45° FOV. Color fundus photograph
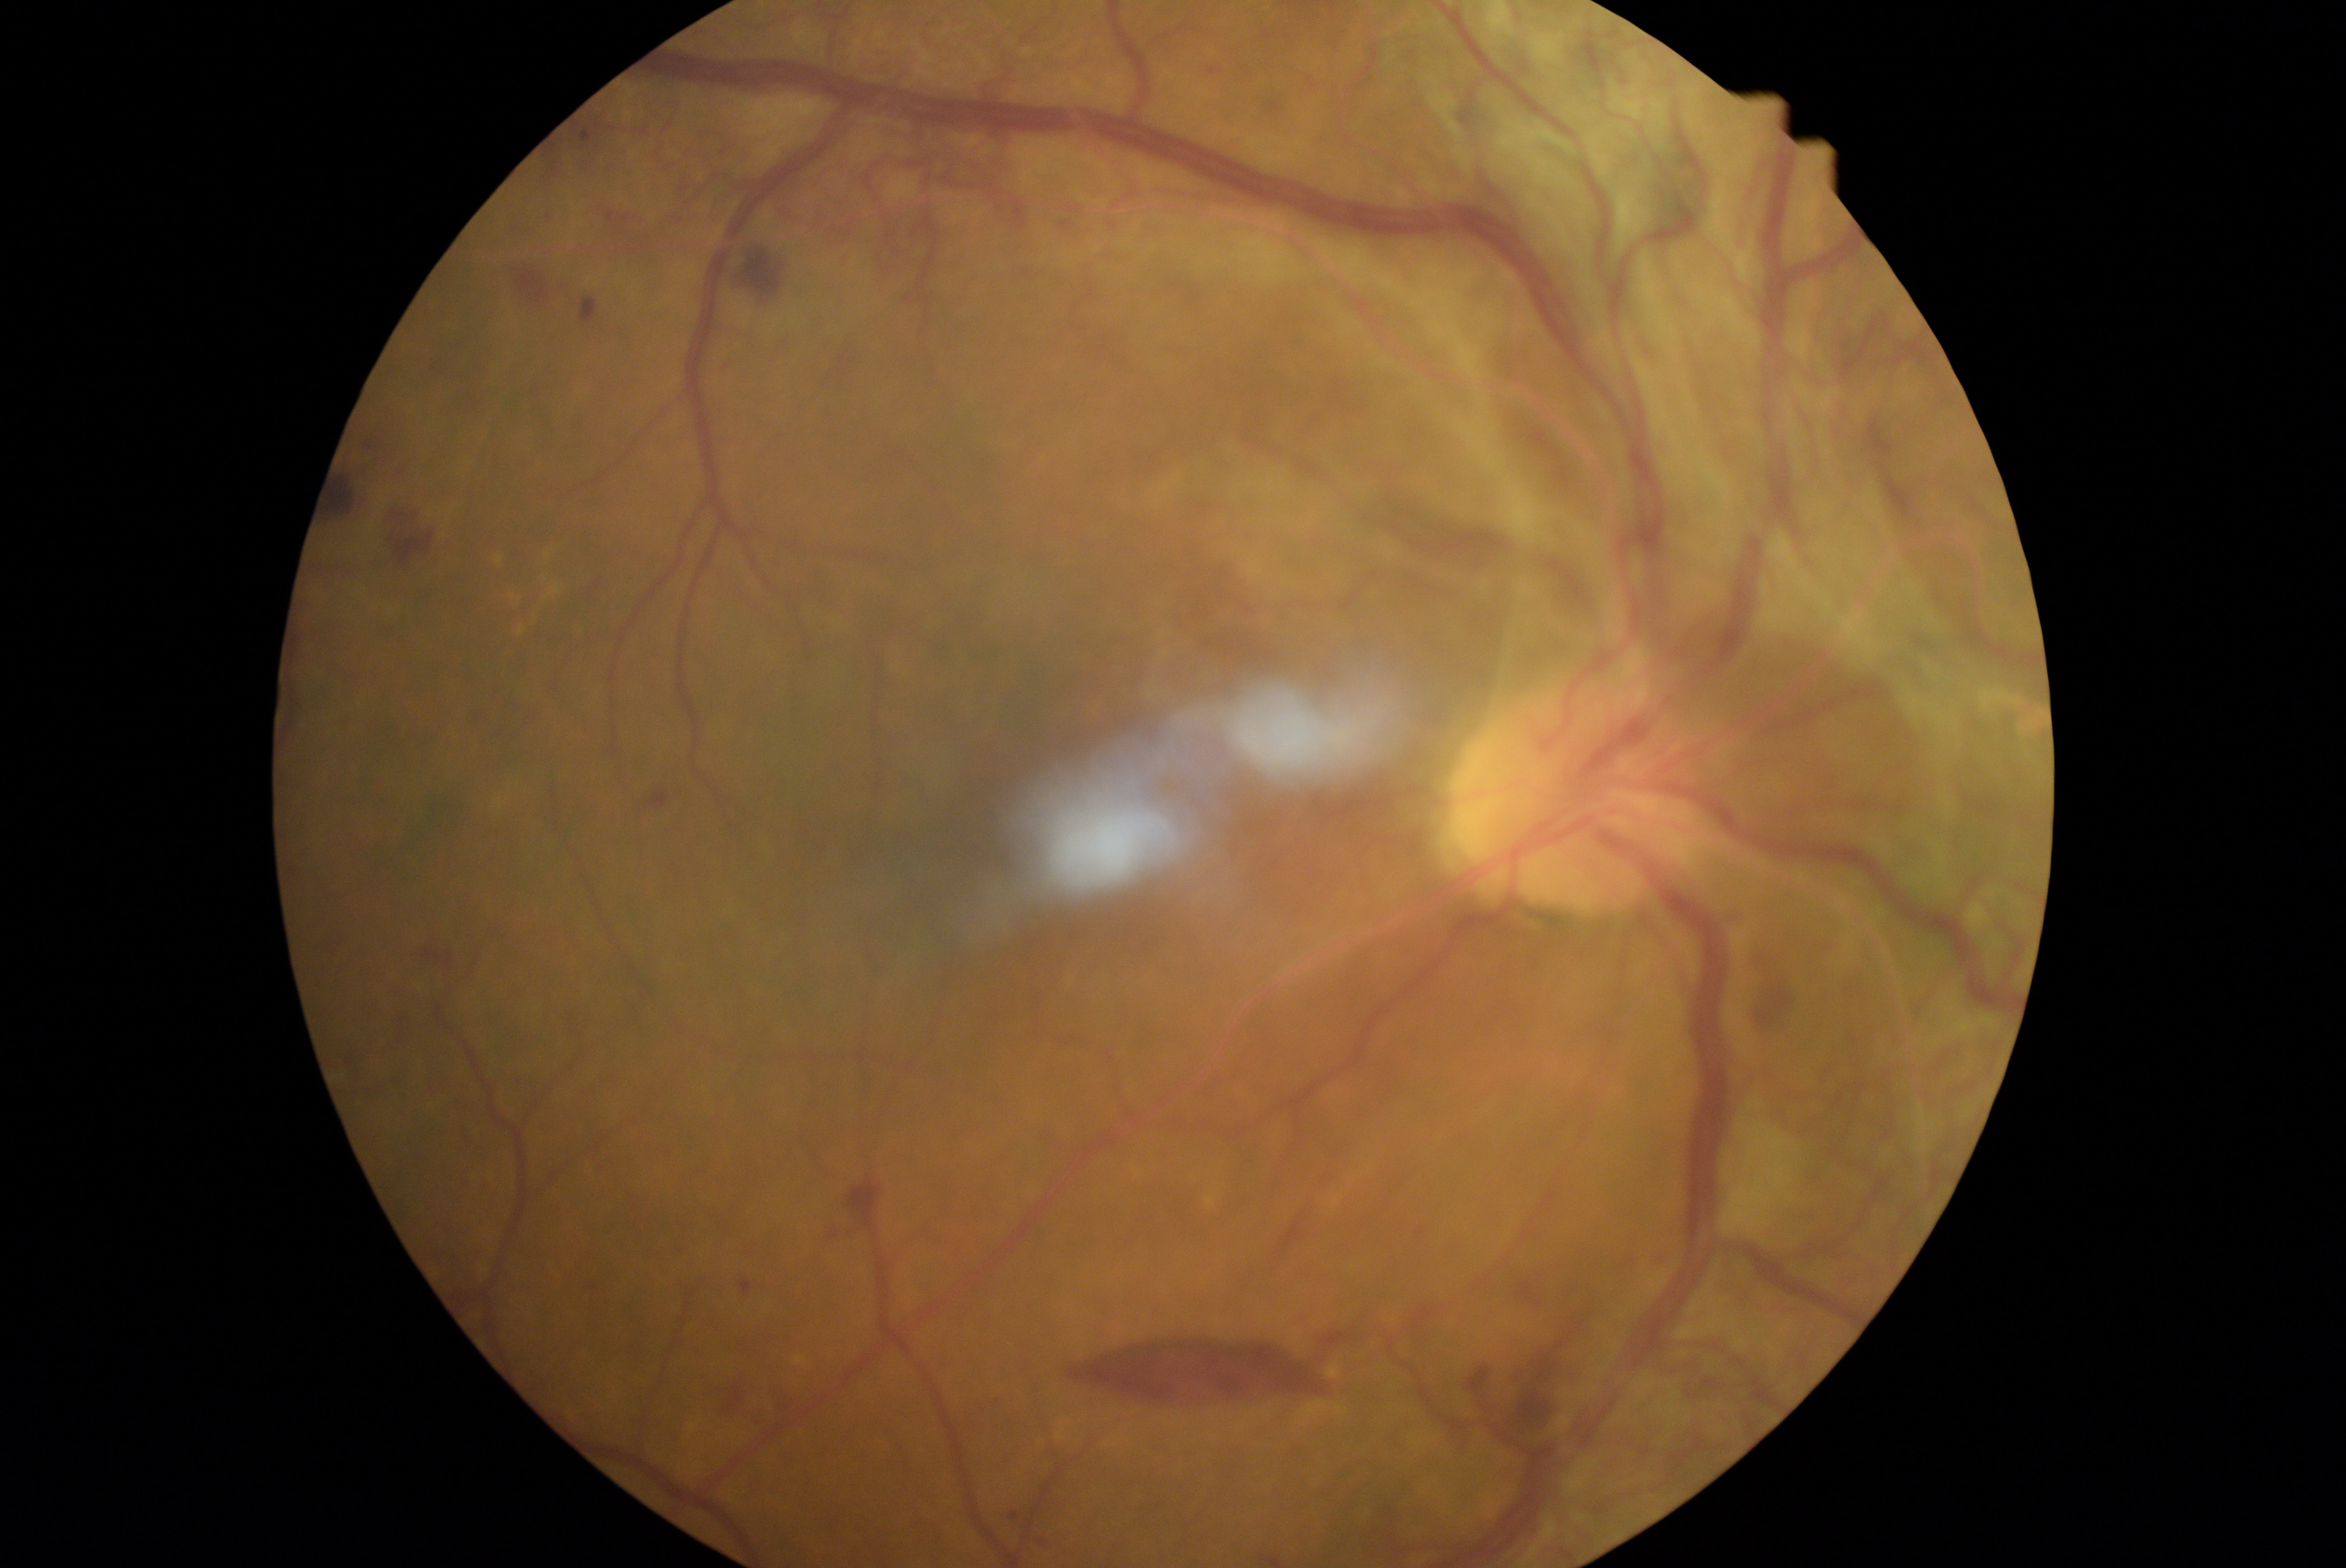

Diabetic retinopathy: grade 4 (PDR).